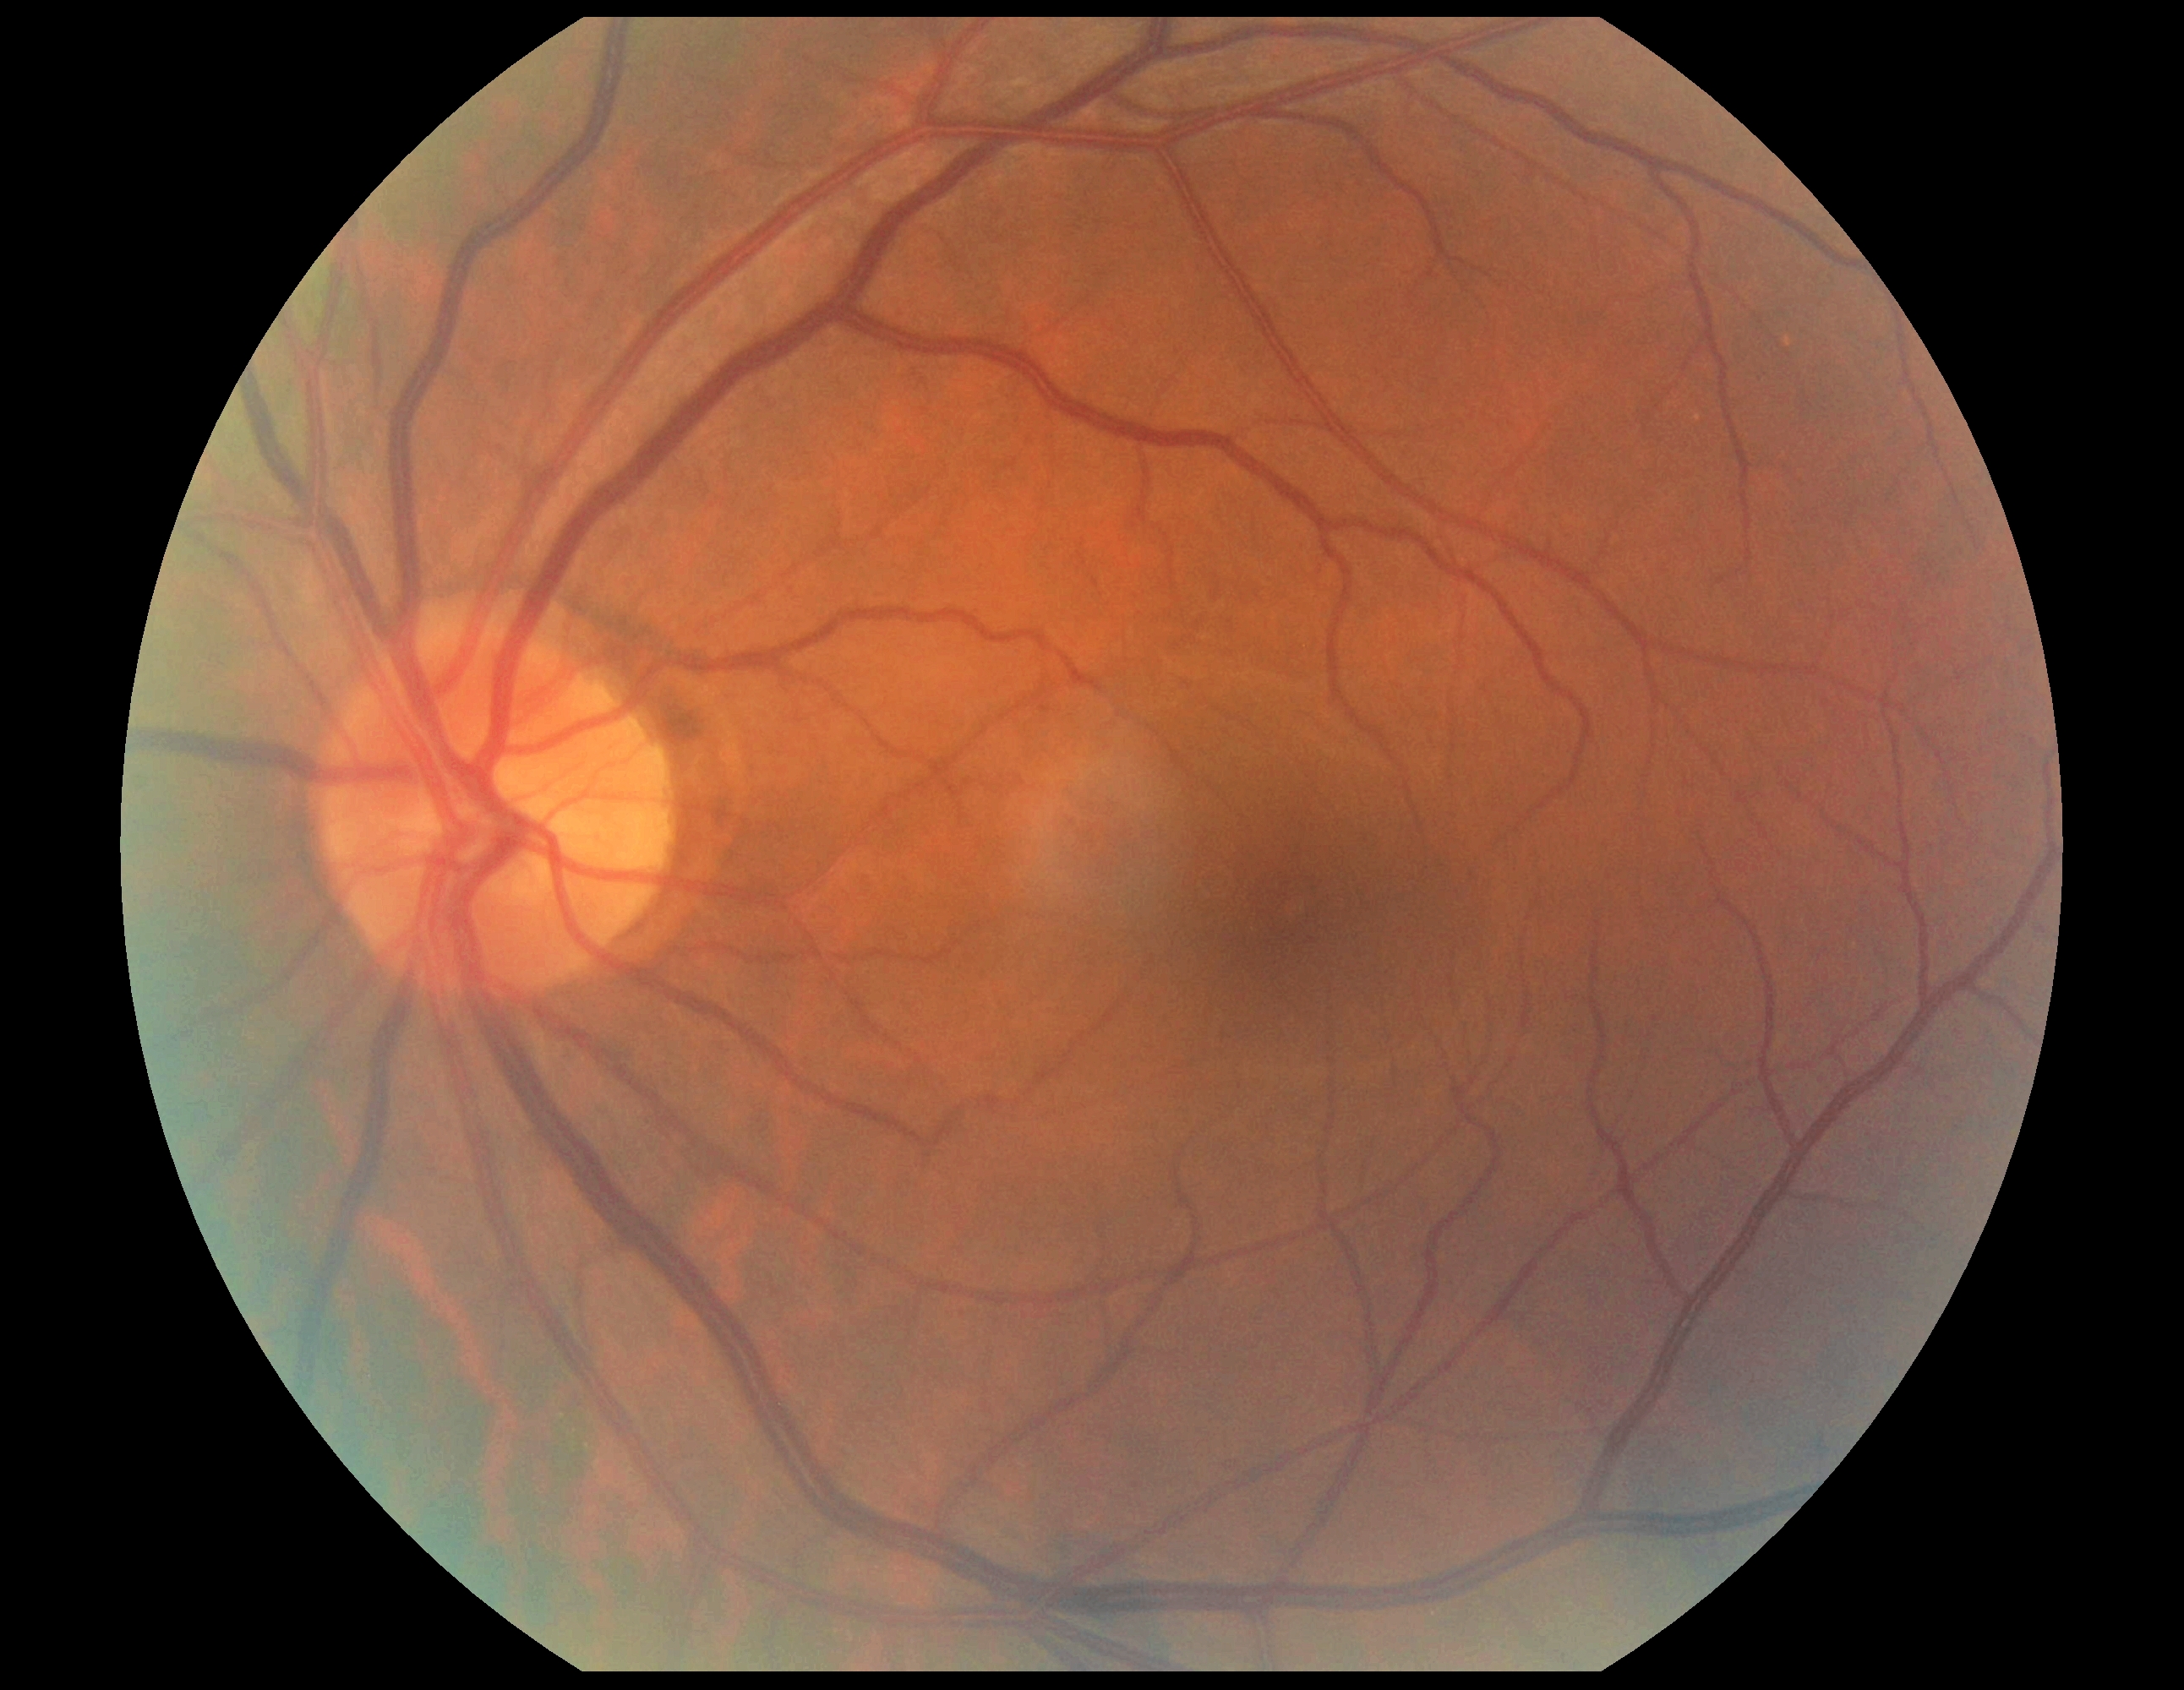
diabetic retinopathy (DR) = 0/4.